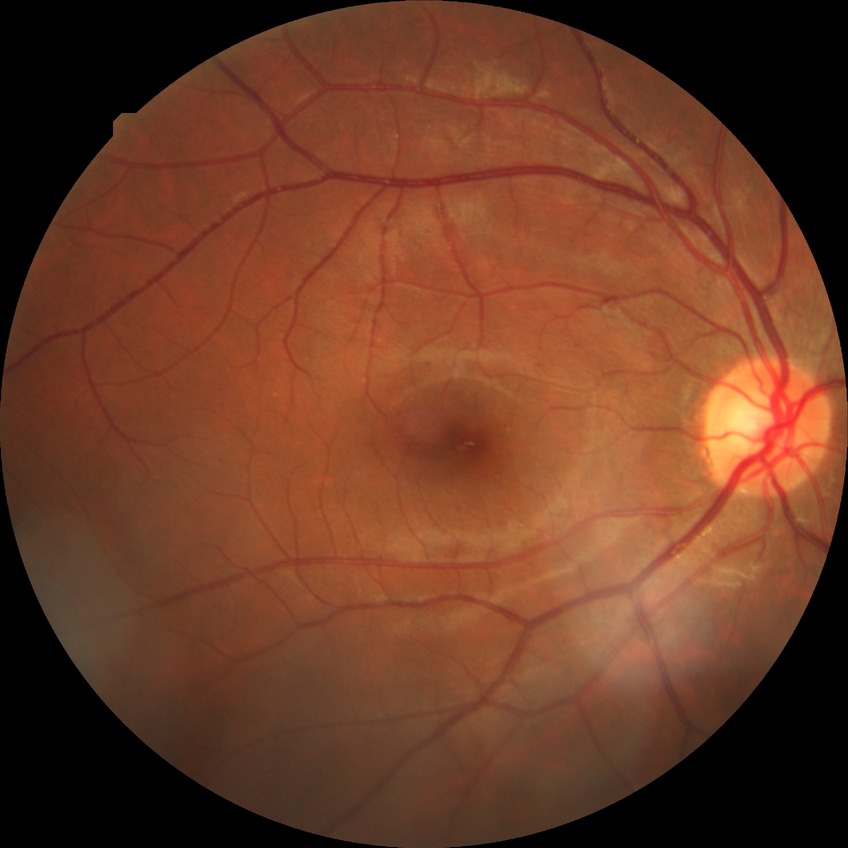 The retinopathy is classified as non-proliferative diabetic retinopathy.
Diabetic retinopathy (DR): SDR (simple diabetic retinopathy).